Captured with the Phoenix ICON (100° field of view); infant wide-field retinal image: 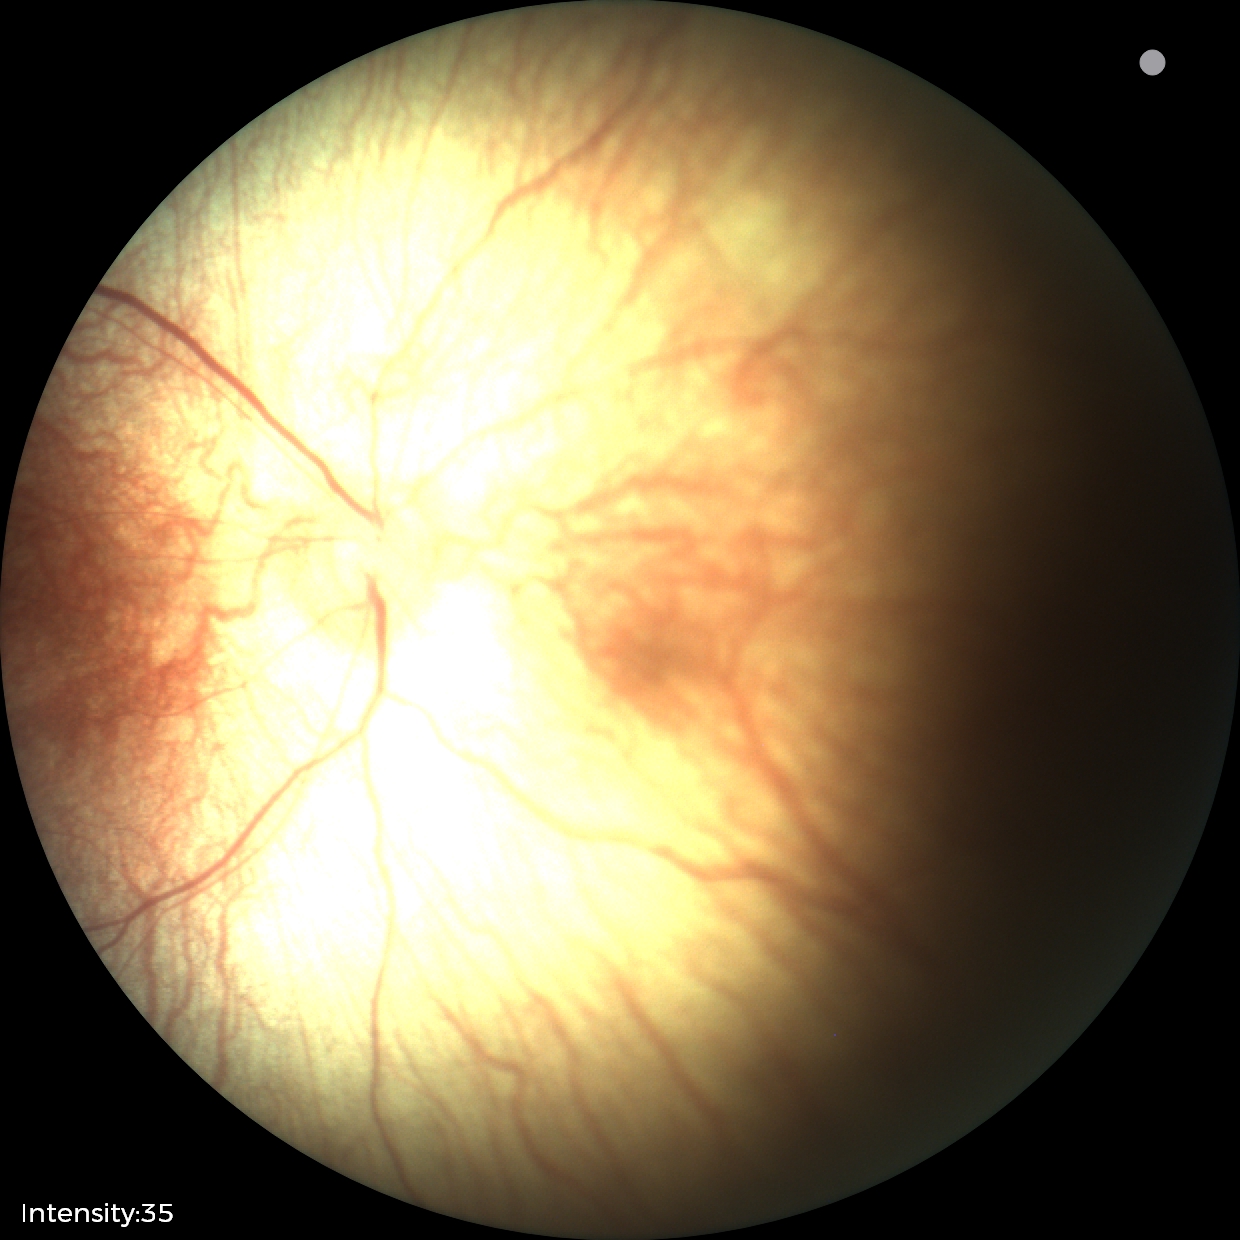 Normal screening examination.